45° FOV:
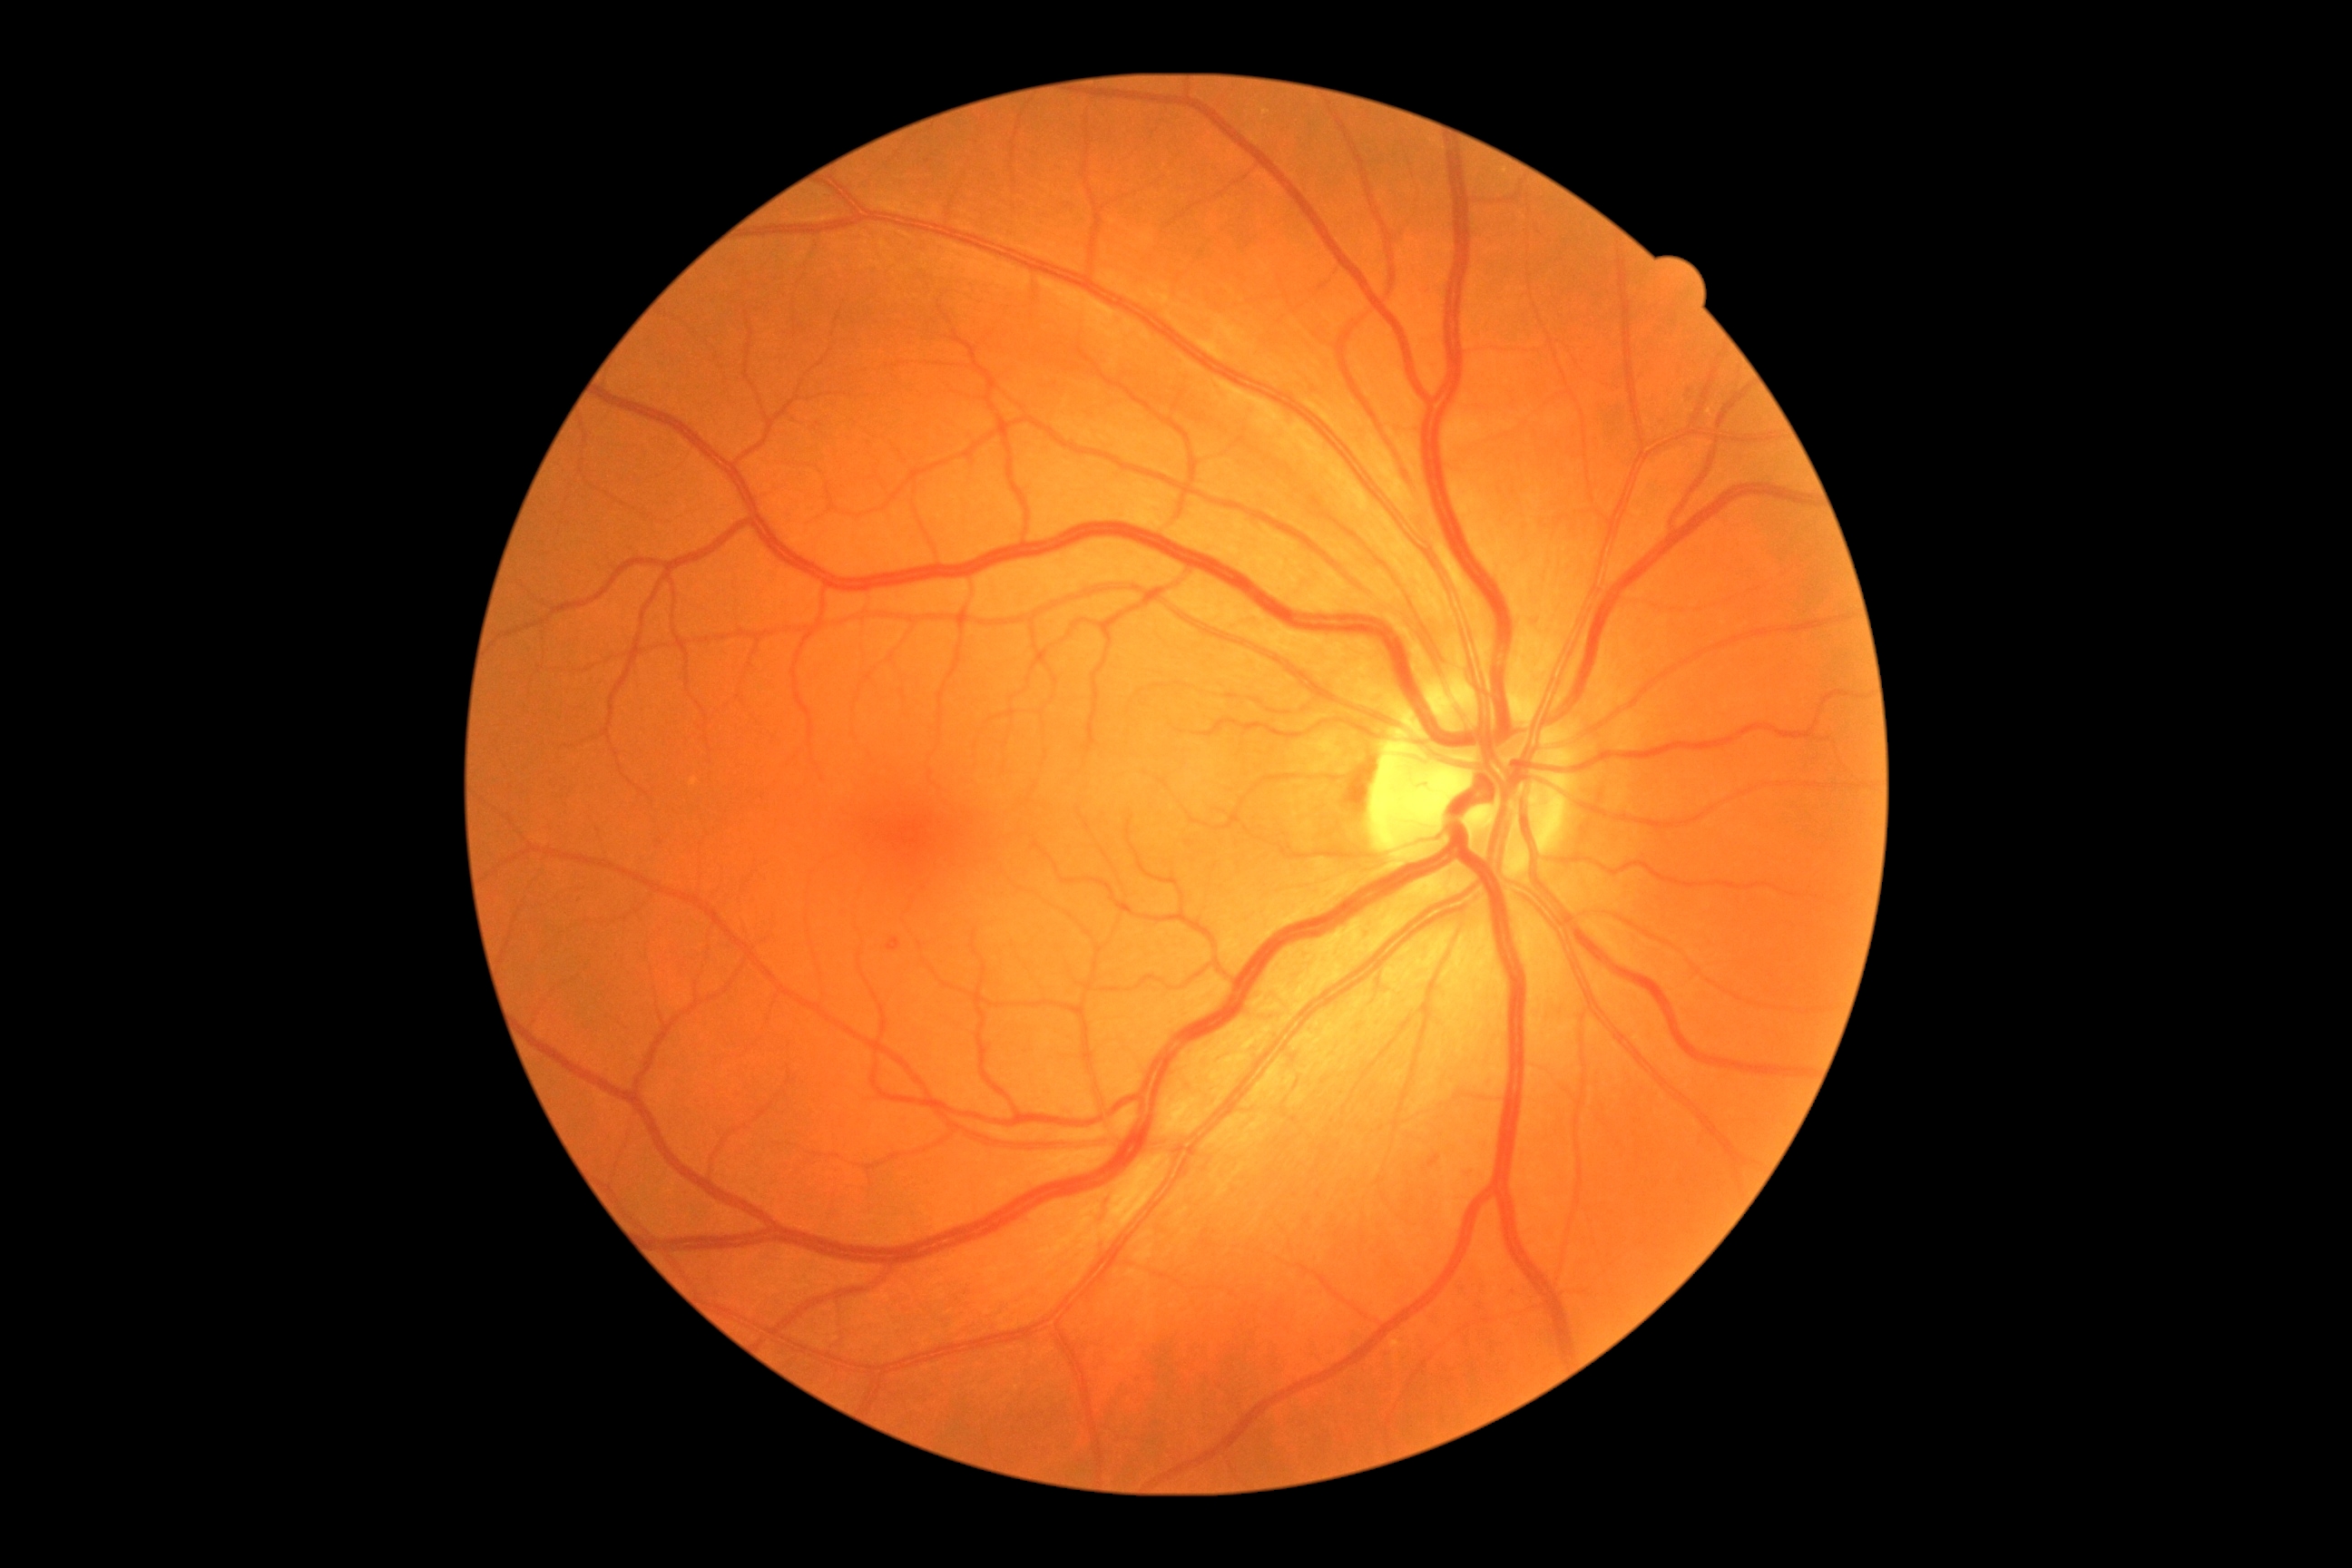

DR severity: grade 1 (mild NPDR).